Infant wide-field fundus photograph
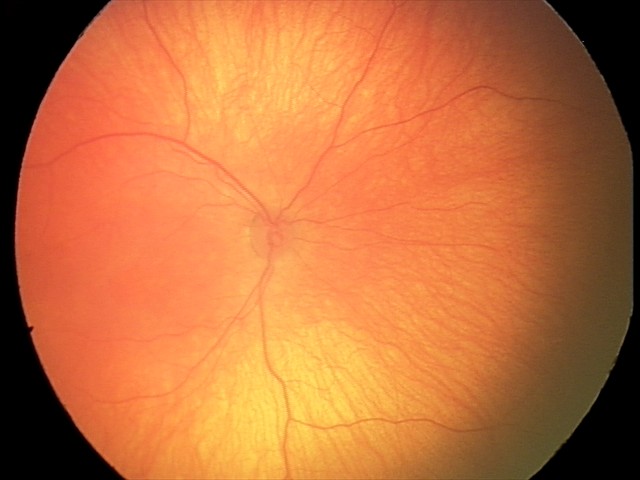

Finding = normal.